FOV: 45 degrees, fundus photo, image size 2352x1568
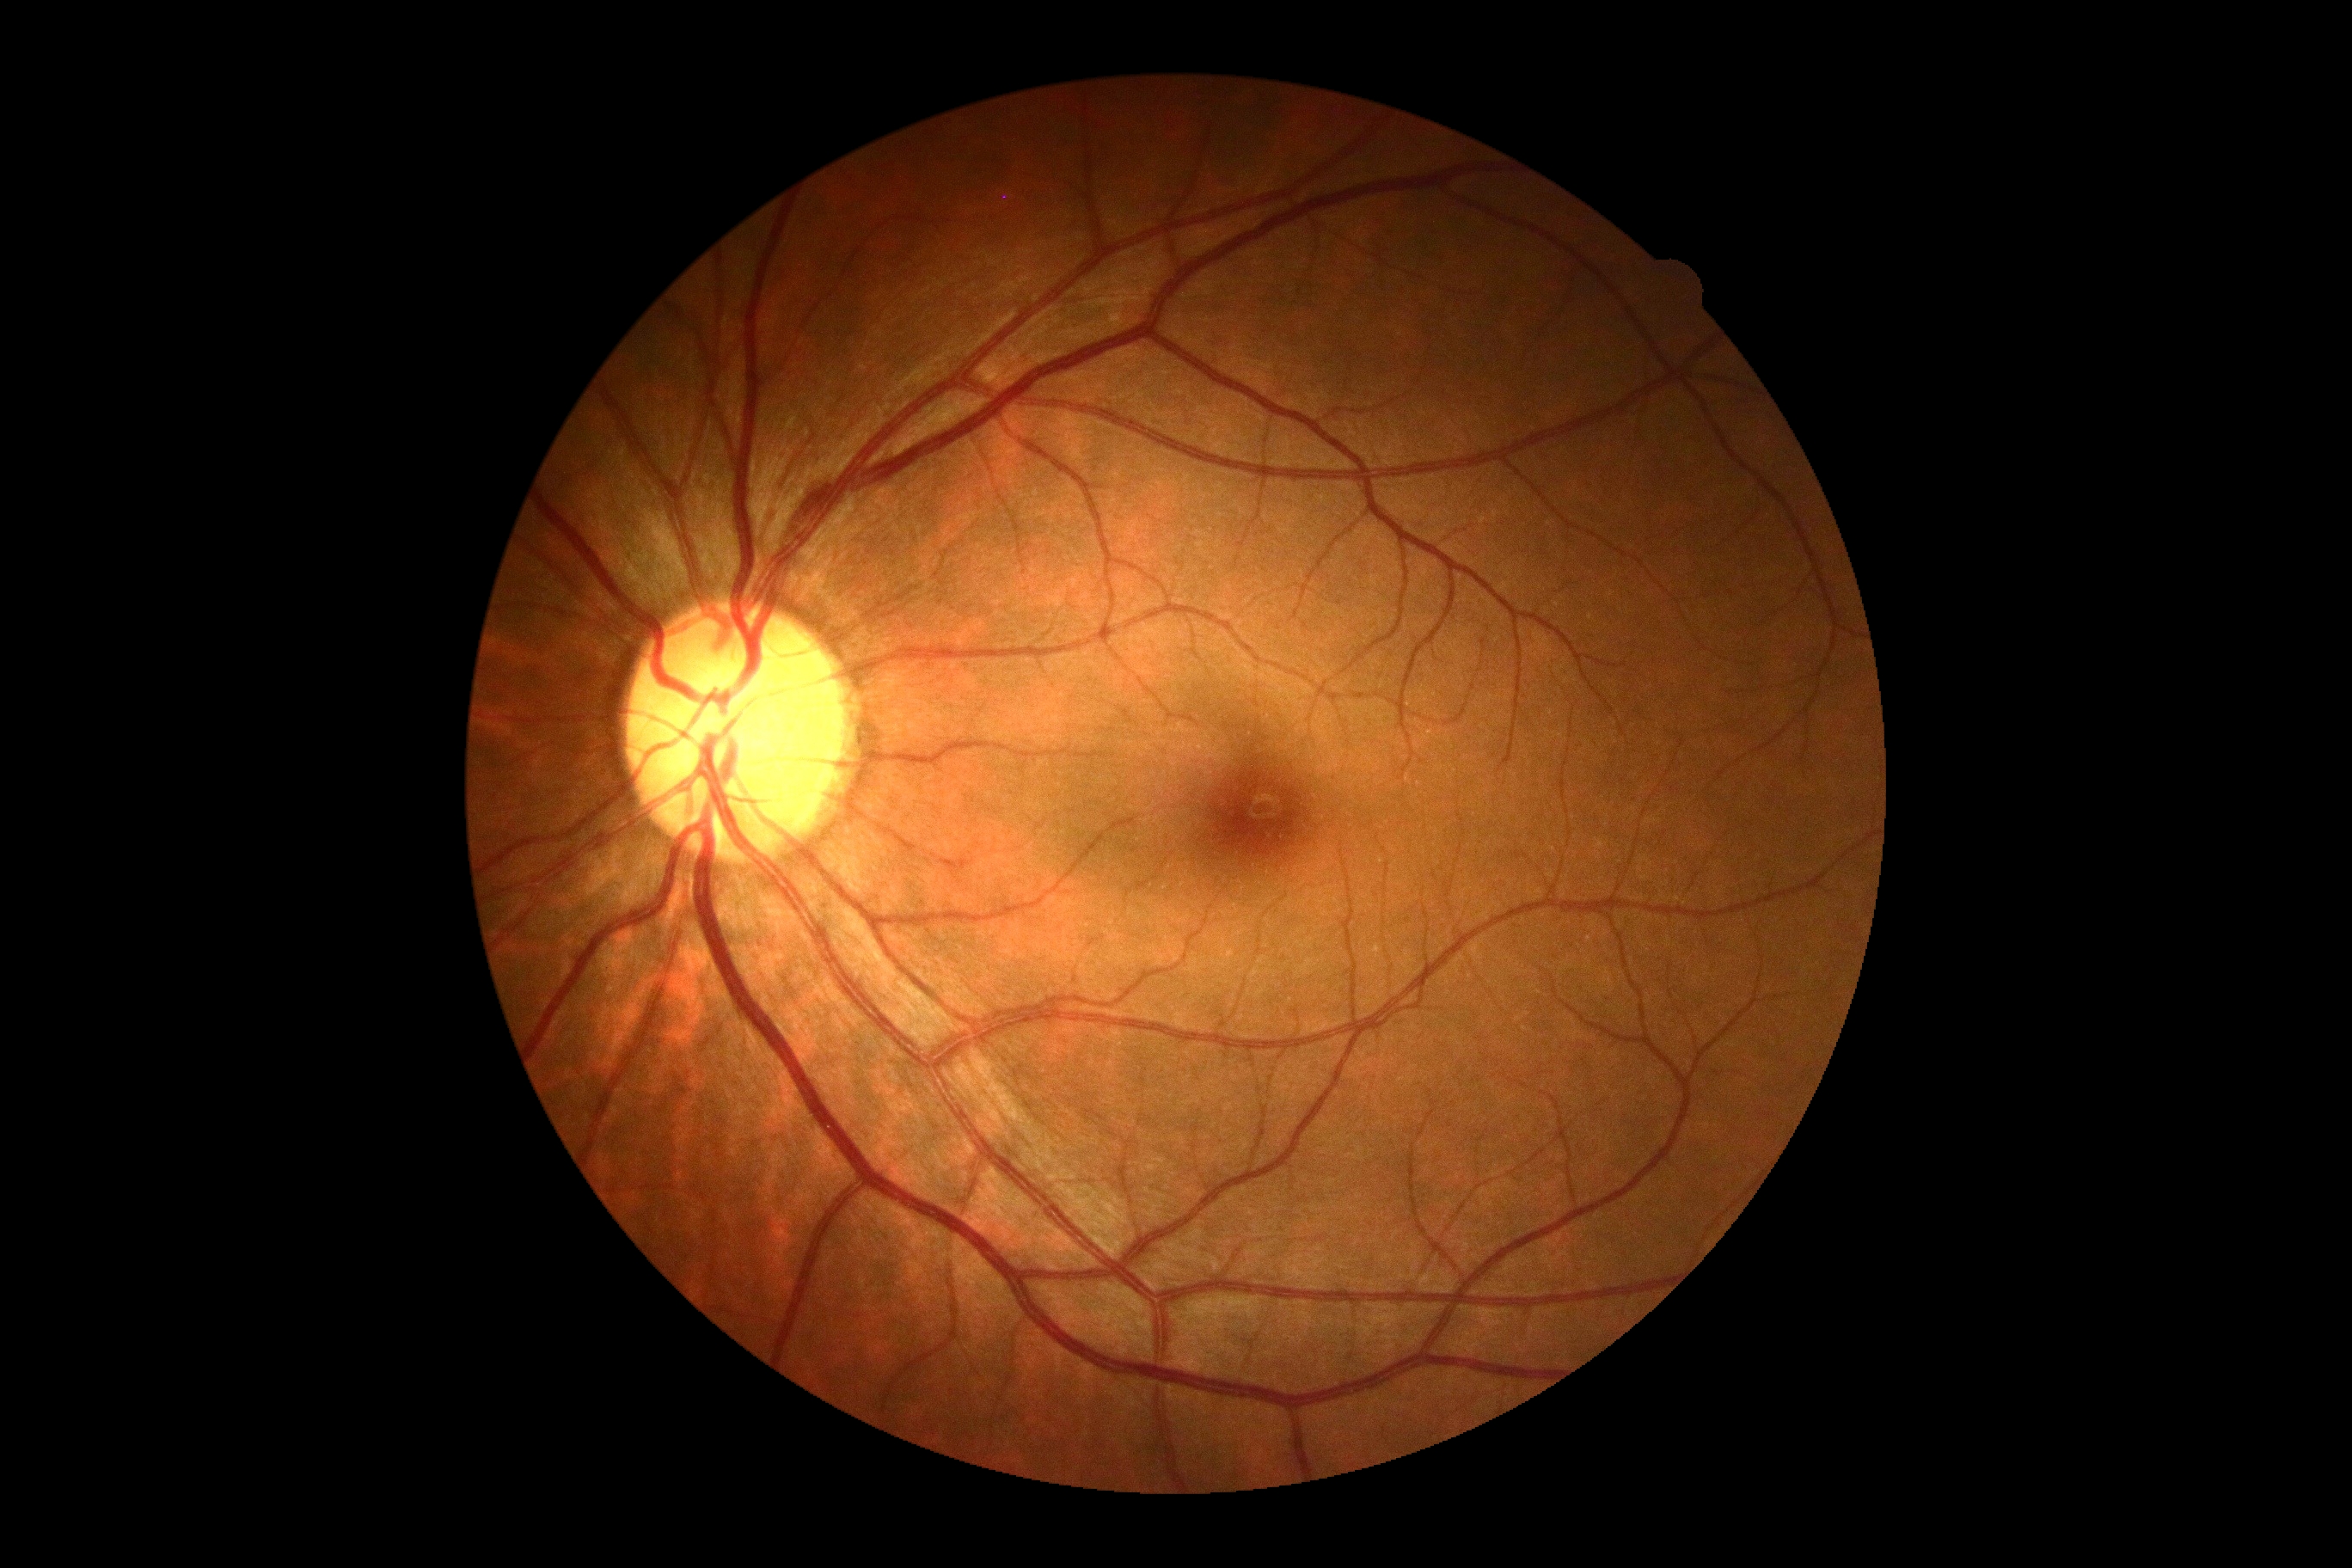

DR: no apparent diabetic retinopathy (grade 0) — no visible signs of diabetic retinopathy.